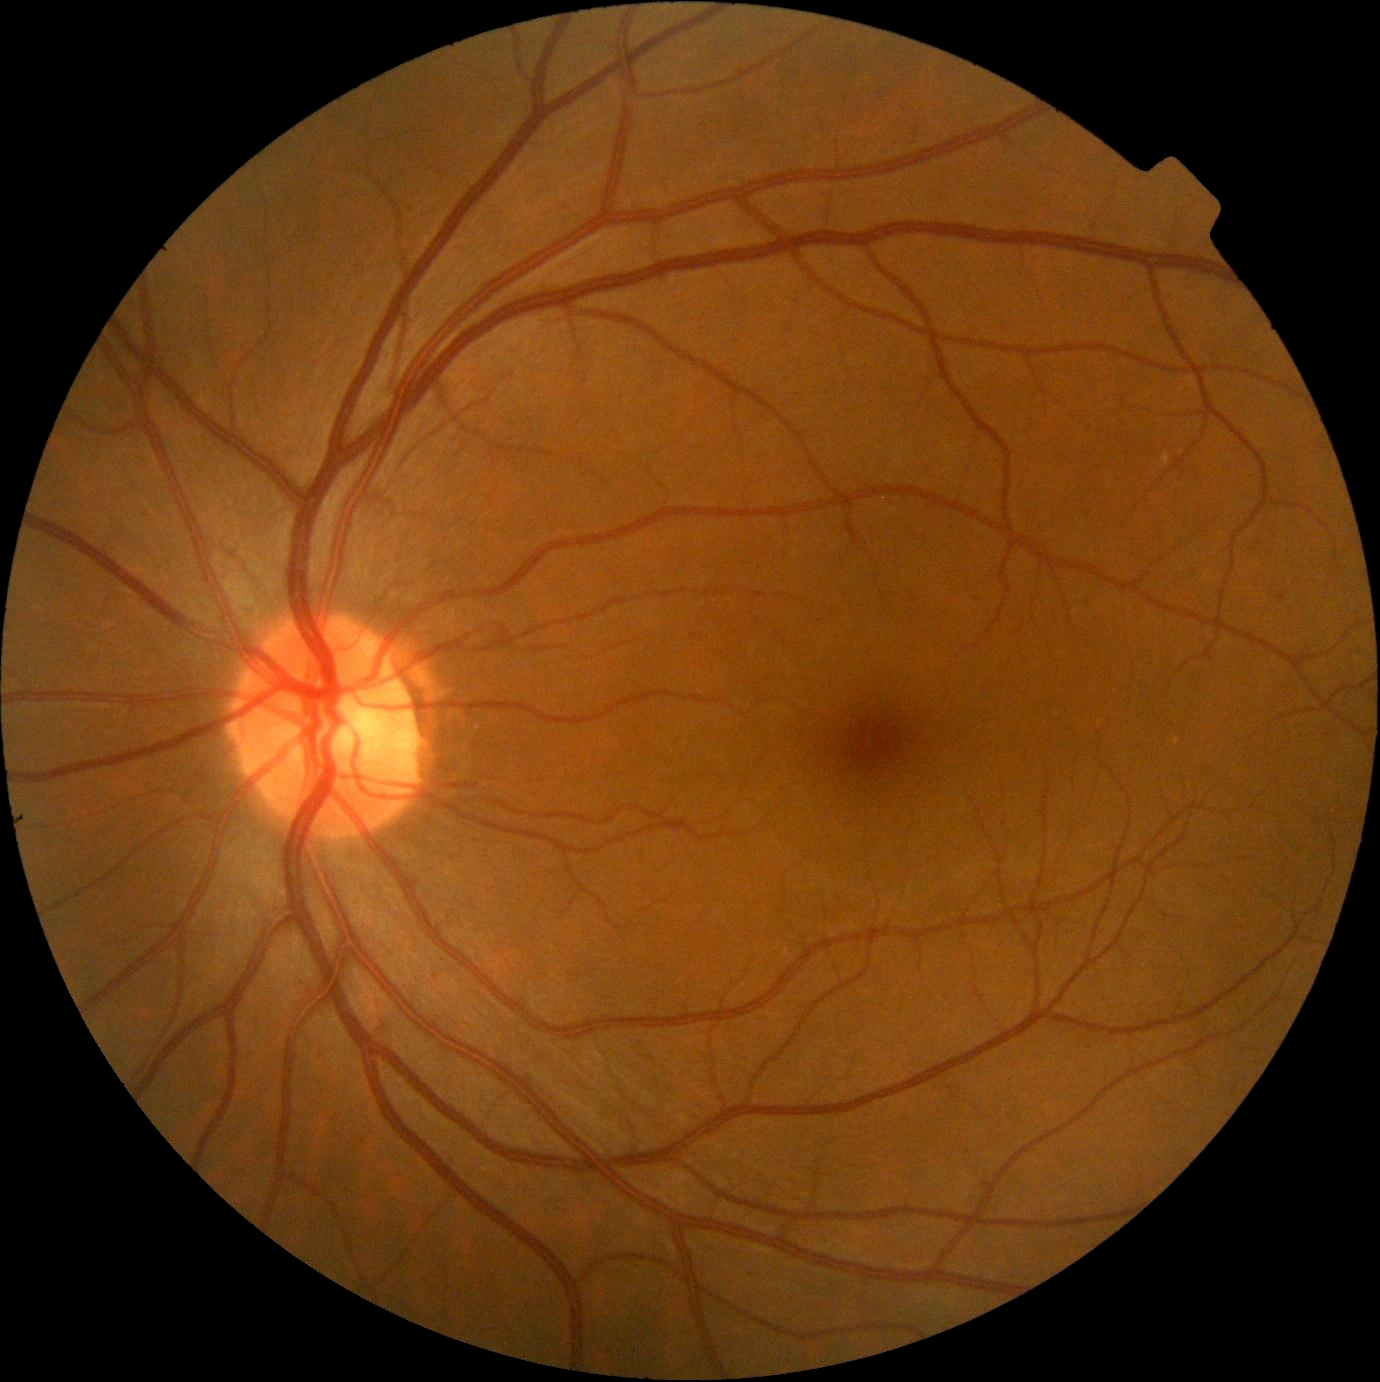 Diabetic retinopathy severity: 0/4. No diabetic retinal disease findings.